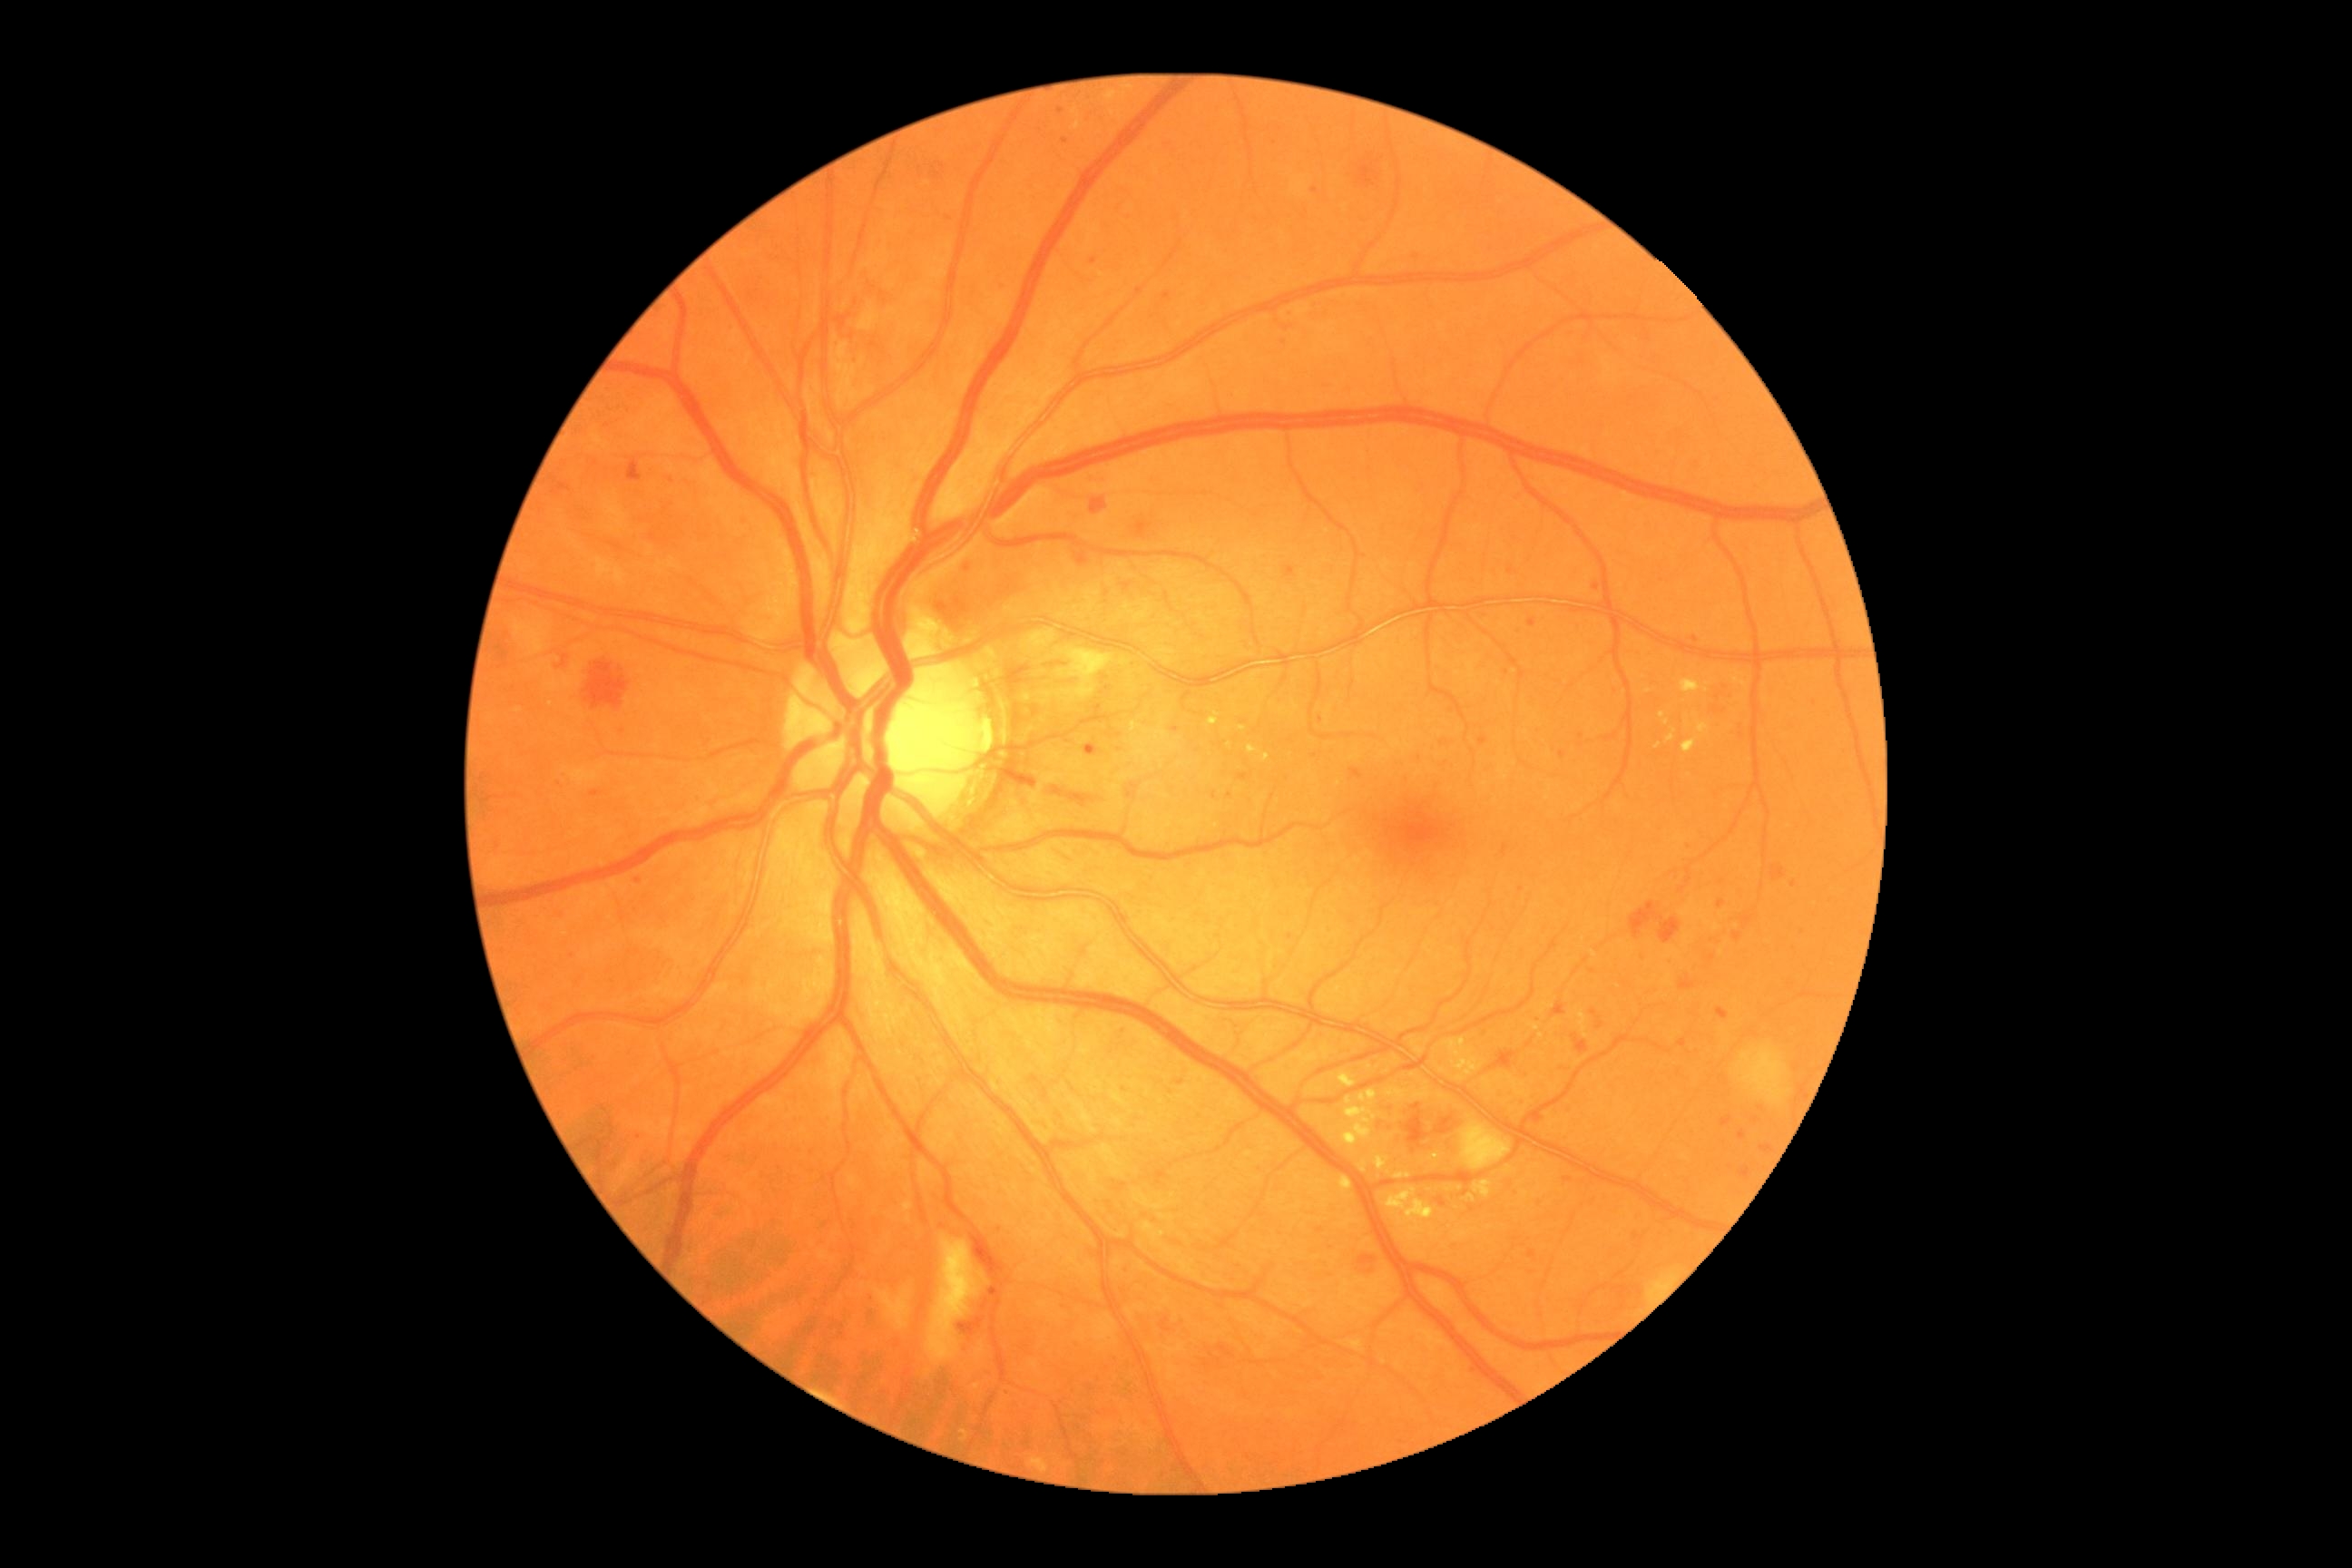

{"partial":true,"dr_grade":3,"dr_grade_name":"severe NPDR","lesions":{"he":[[1761,1146,1770,1153],[498,645,507,660],[959,1317,986,1337],[1591,1010,1603,1030],[1732,932,1743,941],[1741,916,1754,930],[1132,514,1152,533],[1680,977,1696,990],[553,482,571,496],[1480,738,1487,747],[1740,1168,1750,1179],[1573,1035,1589,1055],[1075,547,1088,565],[1406,1104,1429,1148],[1440,741,1449,747],[934,598,945,612],[1358,164,1380,186],[1631,903,1681,945]],"ma":[[1213,792,1217,801],[556,779,560,790],[1004,1389,1012,1396],[1086,743,1095,752],[1690,636,1700,643],[1738,1132,1747,1141]],"ma_small_approx":[[634,910],[1314,191],[562,772],[1288,312],[1540,1204],[1532,1273],[1123,1090],[1288,574],[1515,1194],[1507,673],[1521,890]],"ex":[[1464,1195,1476,1202],[961,1429,970,1442],[1529,1024,1540,1032],[1262,754,1271,763],[1444,1039,1485,1083],[1696,721,1710,736],[1375,1155,1391,1171],[1578,1012,1589,1039],[1338,1177,1353,1199],[1338,1072,1357,1090],[1685,721,1690,729],[1398,1200,1427,1222],[1667,729,1678,743]],"ex_small_approx":[[1443,1071],[1461,1188],[1542,1036]]}}